Acquired with a NIDEK AFC-230. 848x848. Color fundus image. 45 degree fundus photograph.
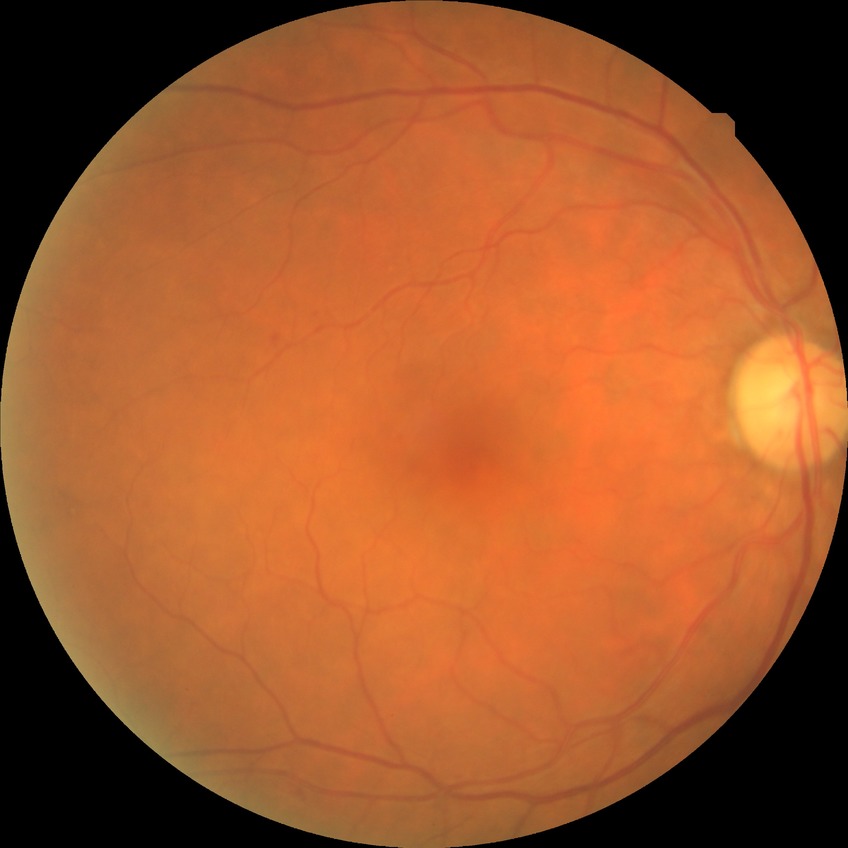

Retinopathy stage is simple diabetic retinopathy.